Retinal fundus photograph; image size 2212x1659.
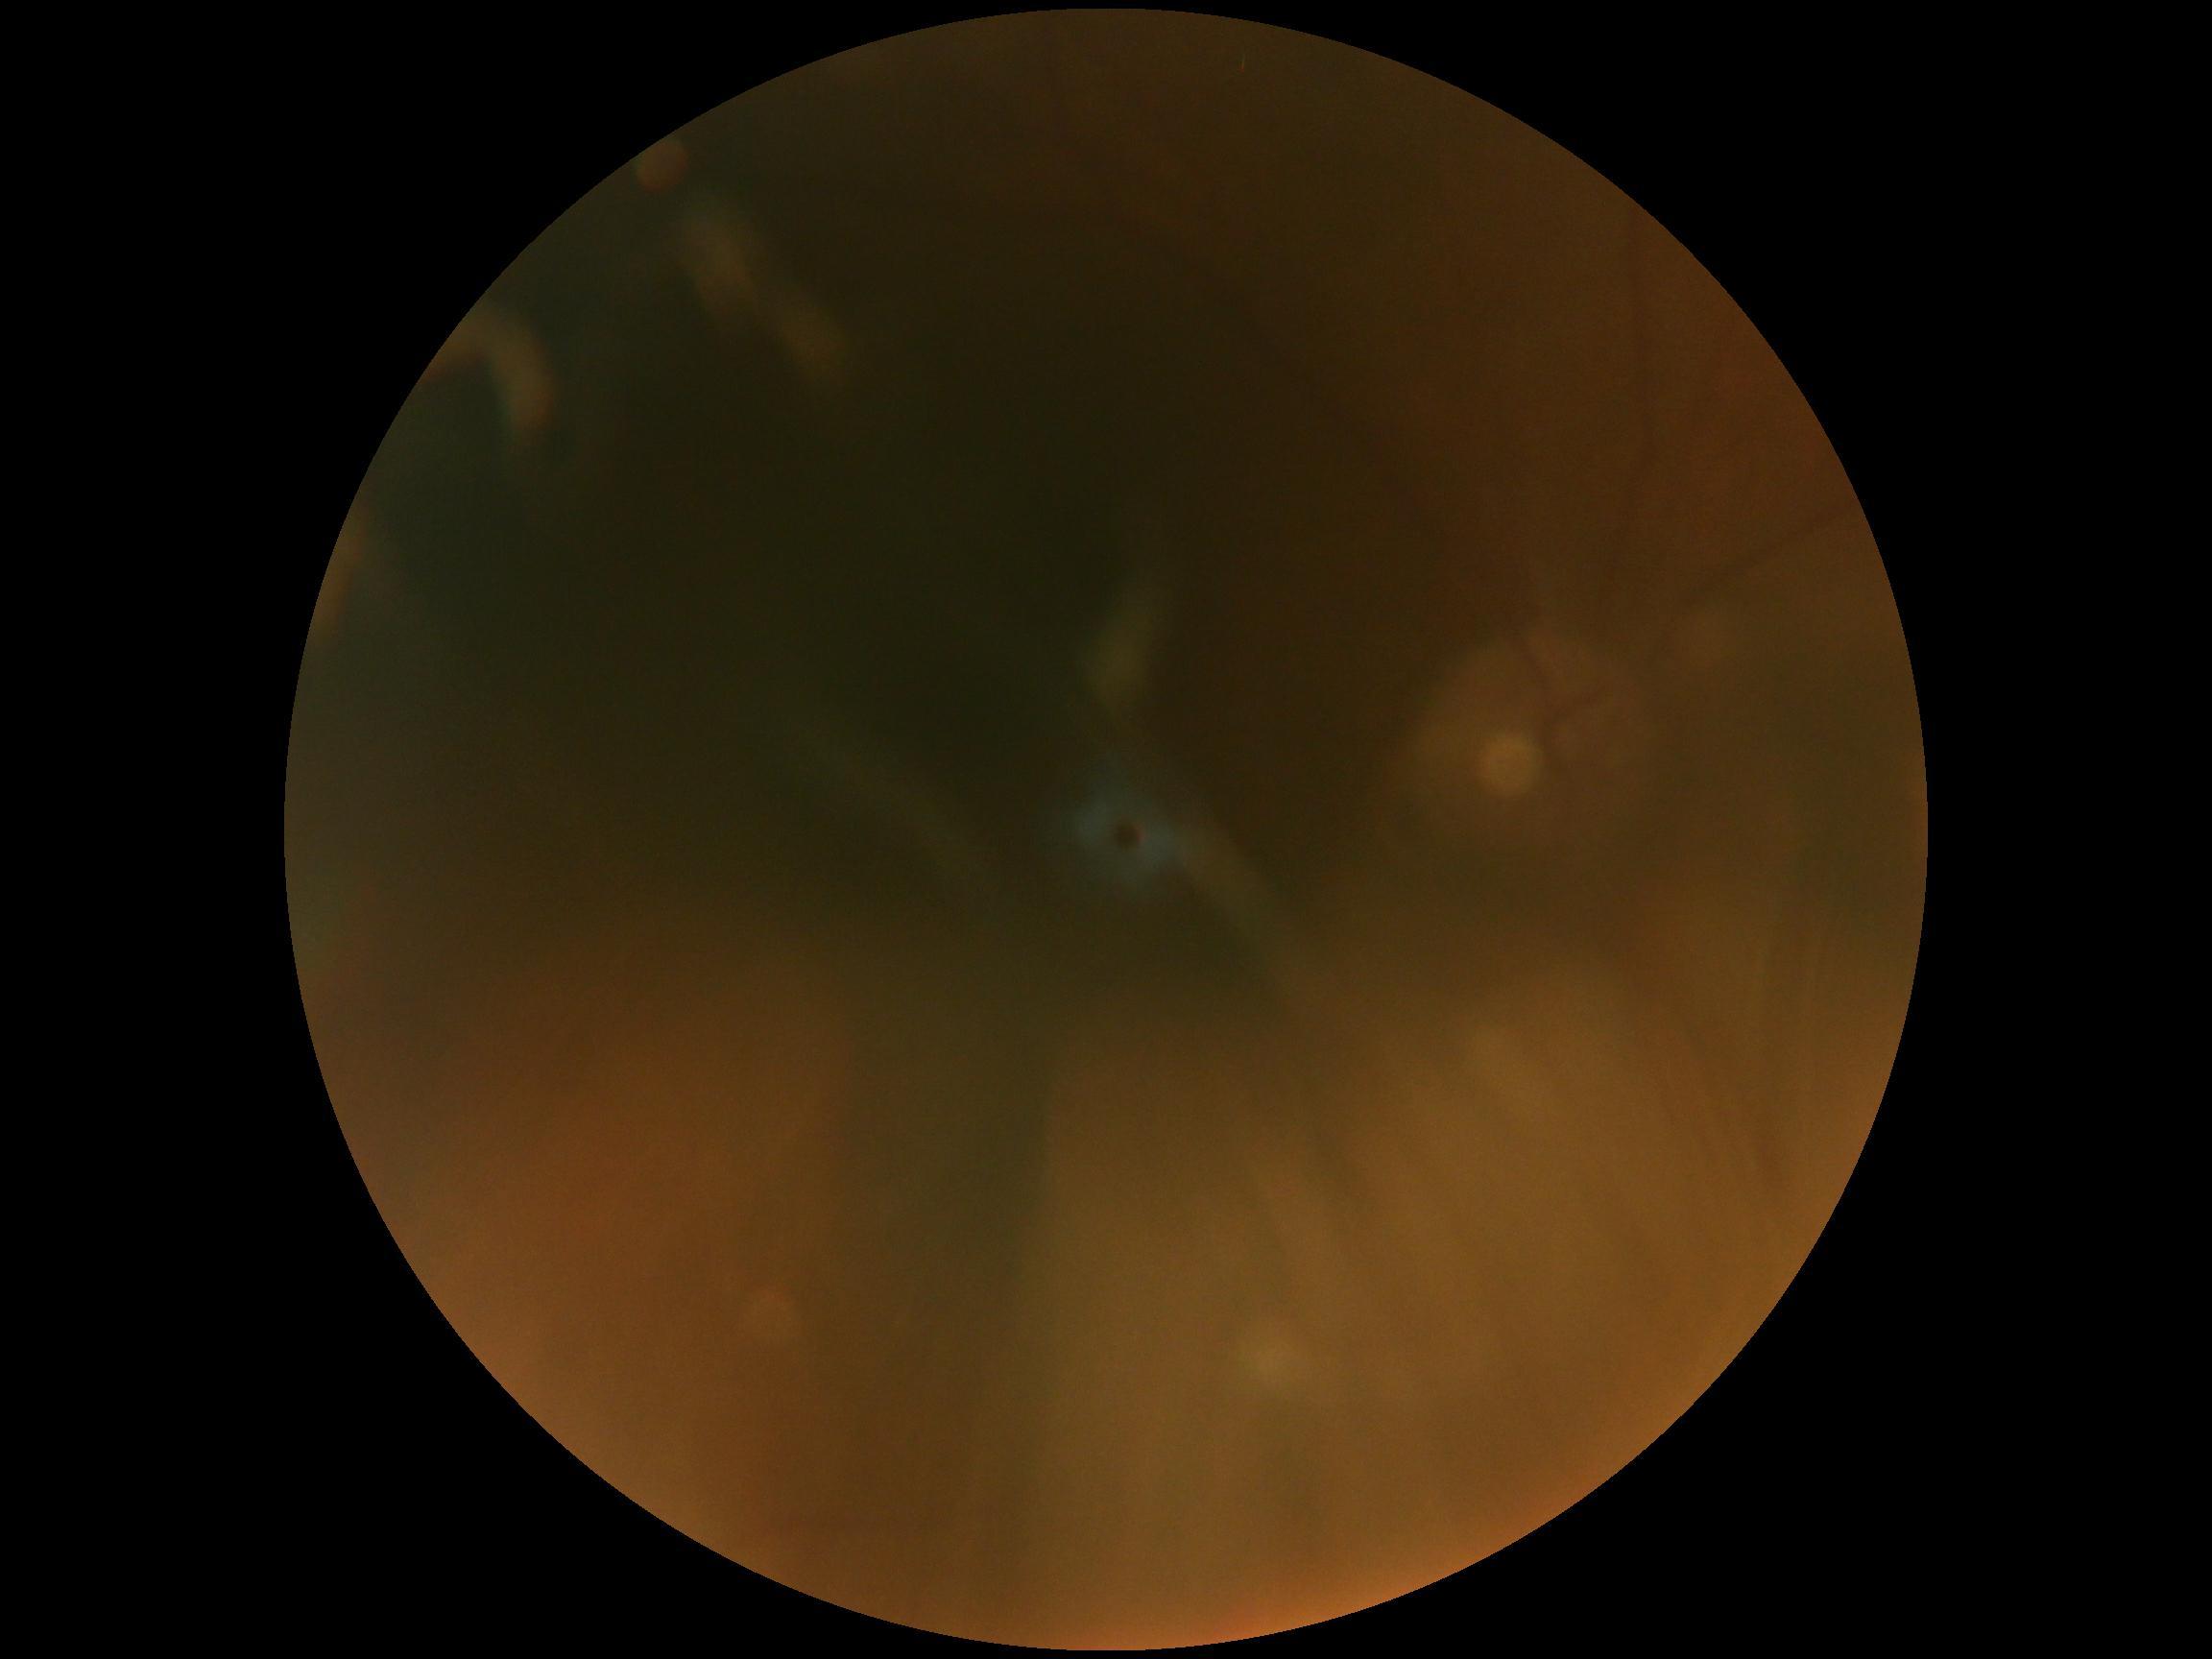 Findings:
– retinopathy — ungradable due to poor image quality
– image quality — insufficient for DR assessment